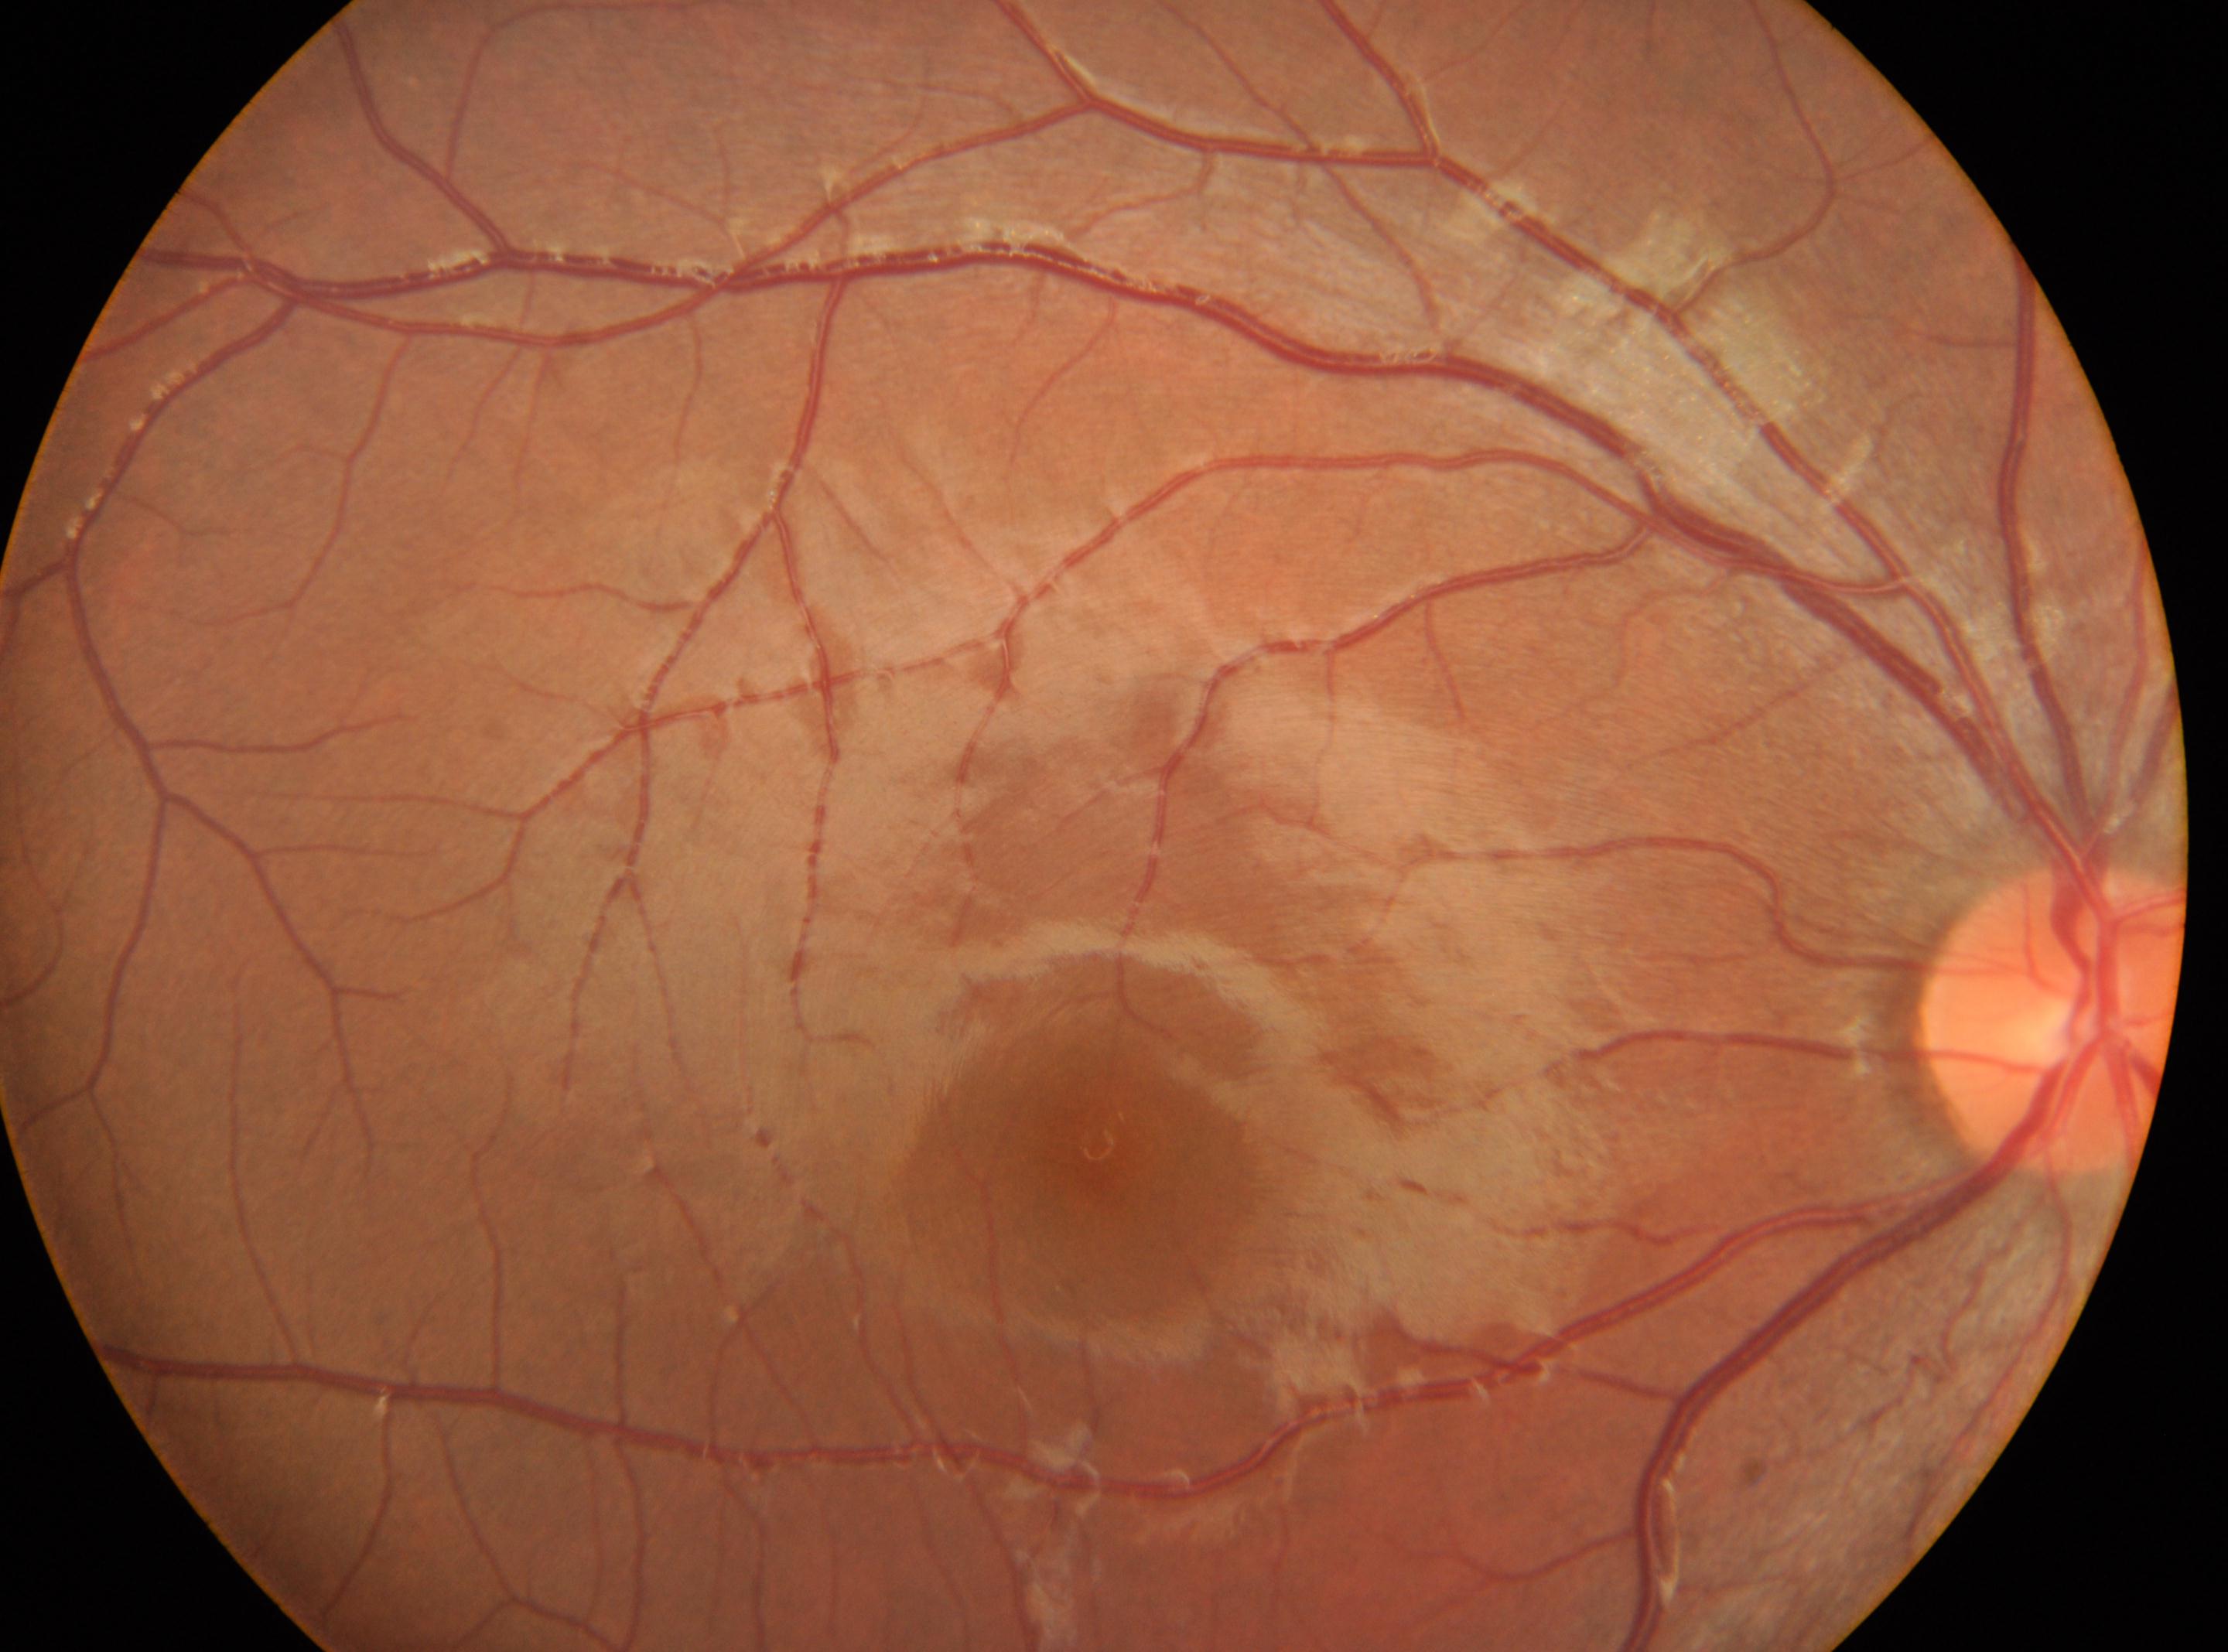 | field | value |
|---|---|
| diabetic retinopathy (DR) | grade 0 — no visible signs of diabetic retinopathy |
| laterality | the right eye |
| DR impression | No apparent diabetic retinopathy |
| optic disc center | [2051, 1019] |
| the fovea | [1099, 1145] |